Non-mydriatic acquisition, 240x240px, CFP:
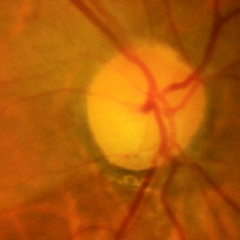 Demonstrates early glaucomatous changes.